Image size 1380x1382: 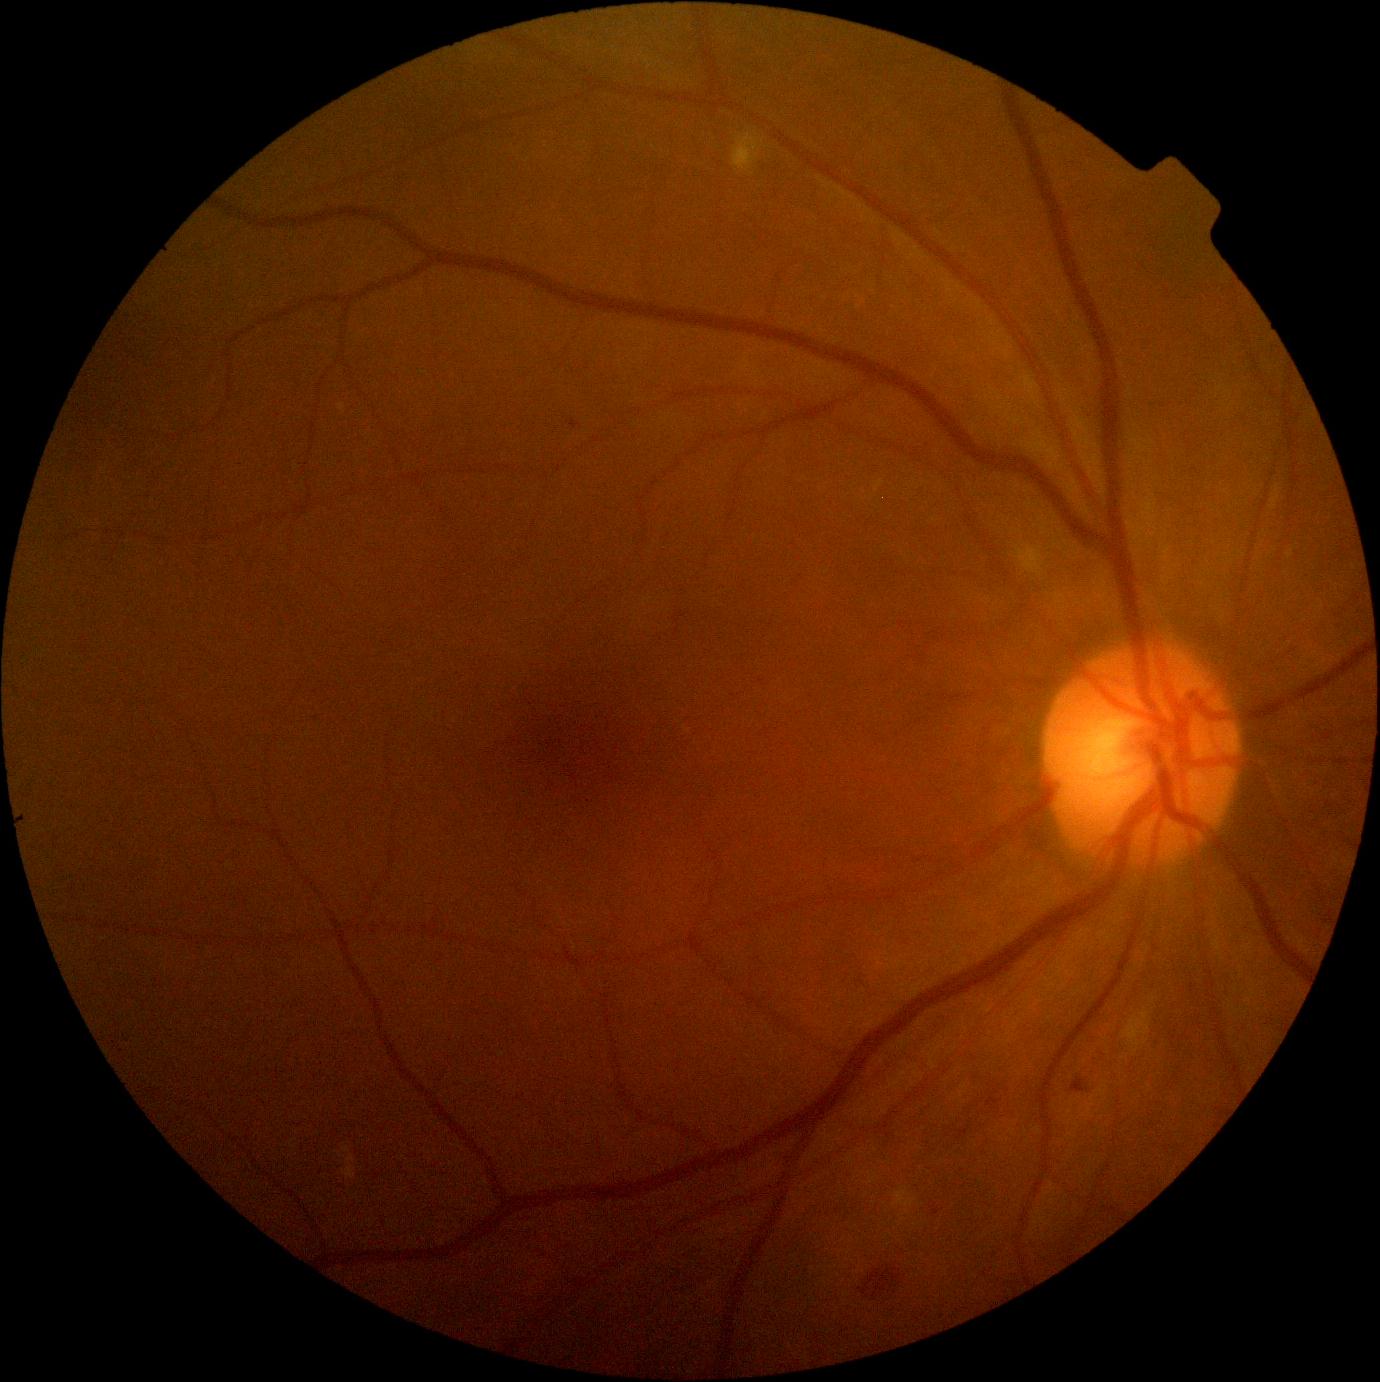

DR class: non-proliferative diabetic retinopathy; diabetic retinopathy grade: moderate non-proliferative diabetic retinopathy (2).